1932 x 1910 pixels. Color fundus image:
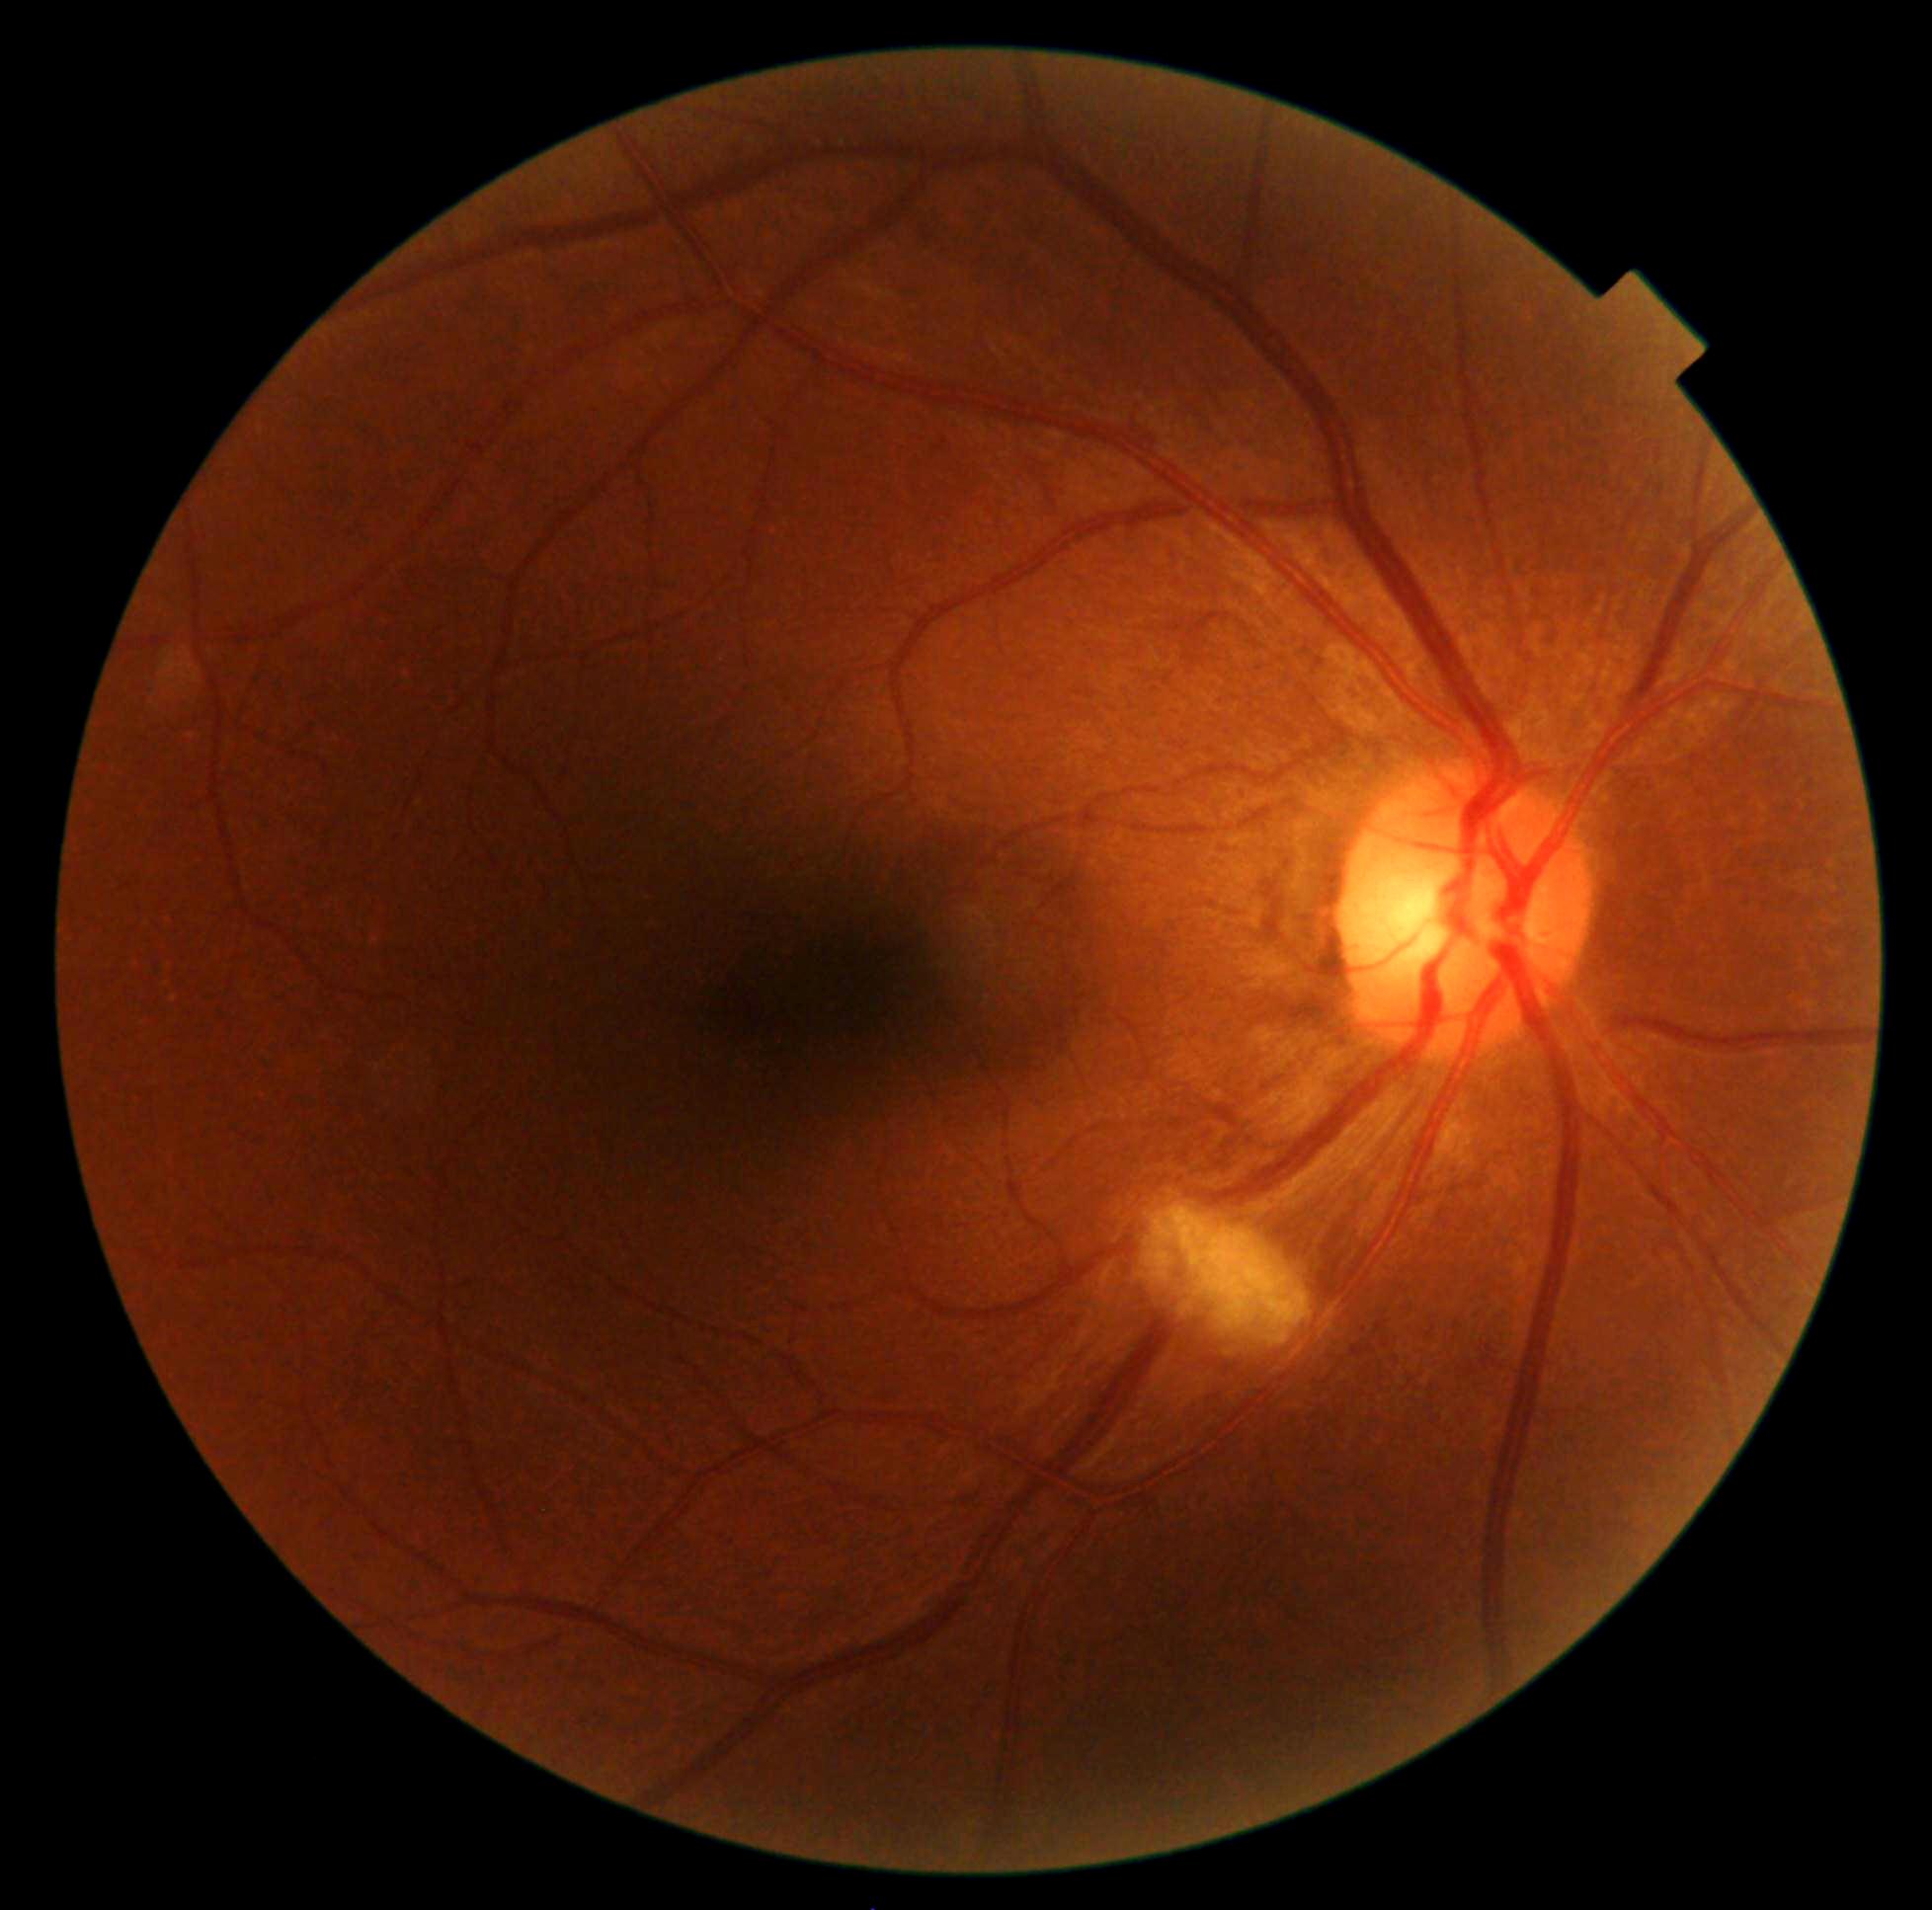 Diabetic retinopathy: grade 2 (moderate NPDR).